Color fundus image: 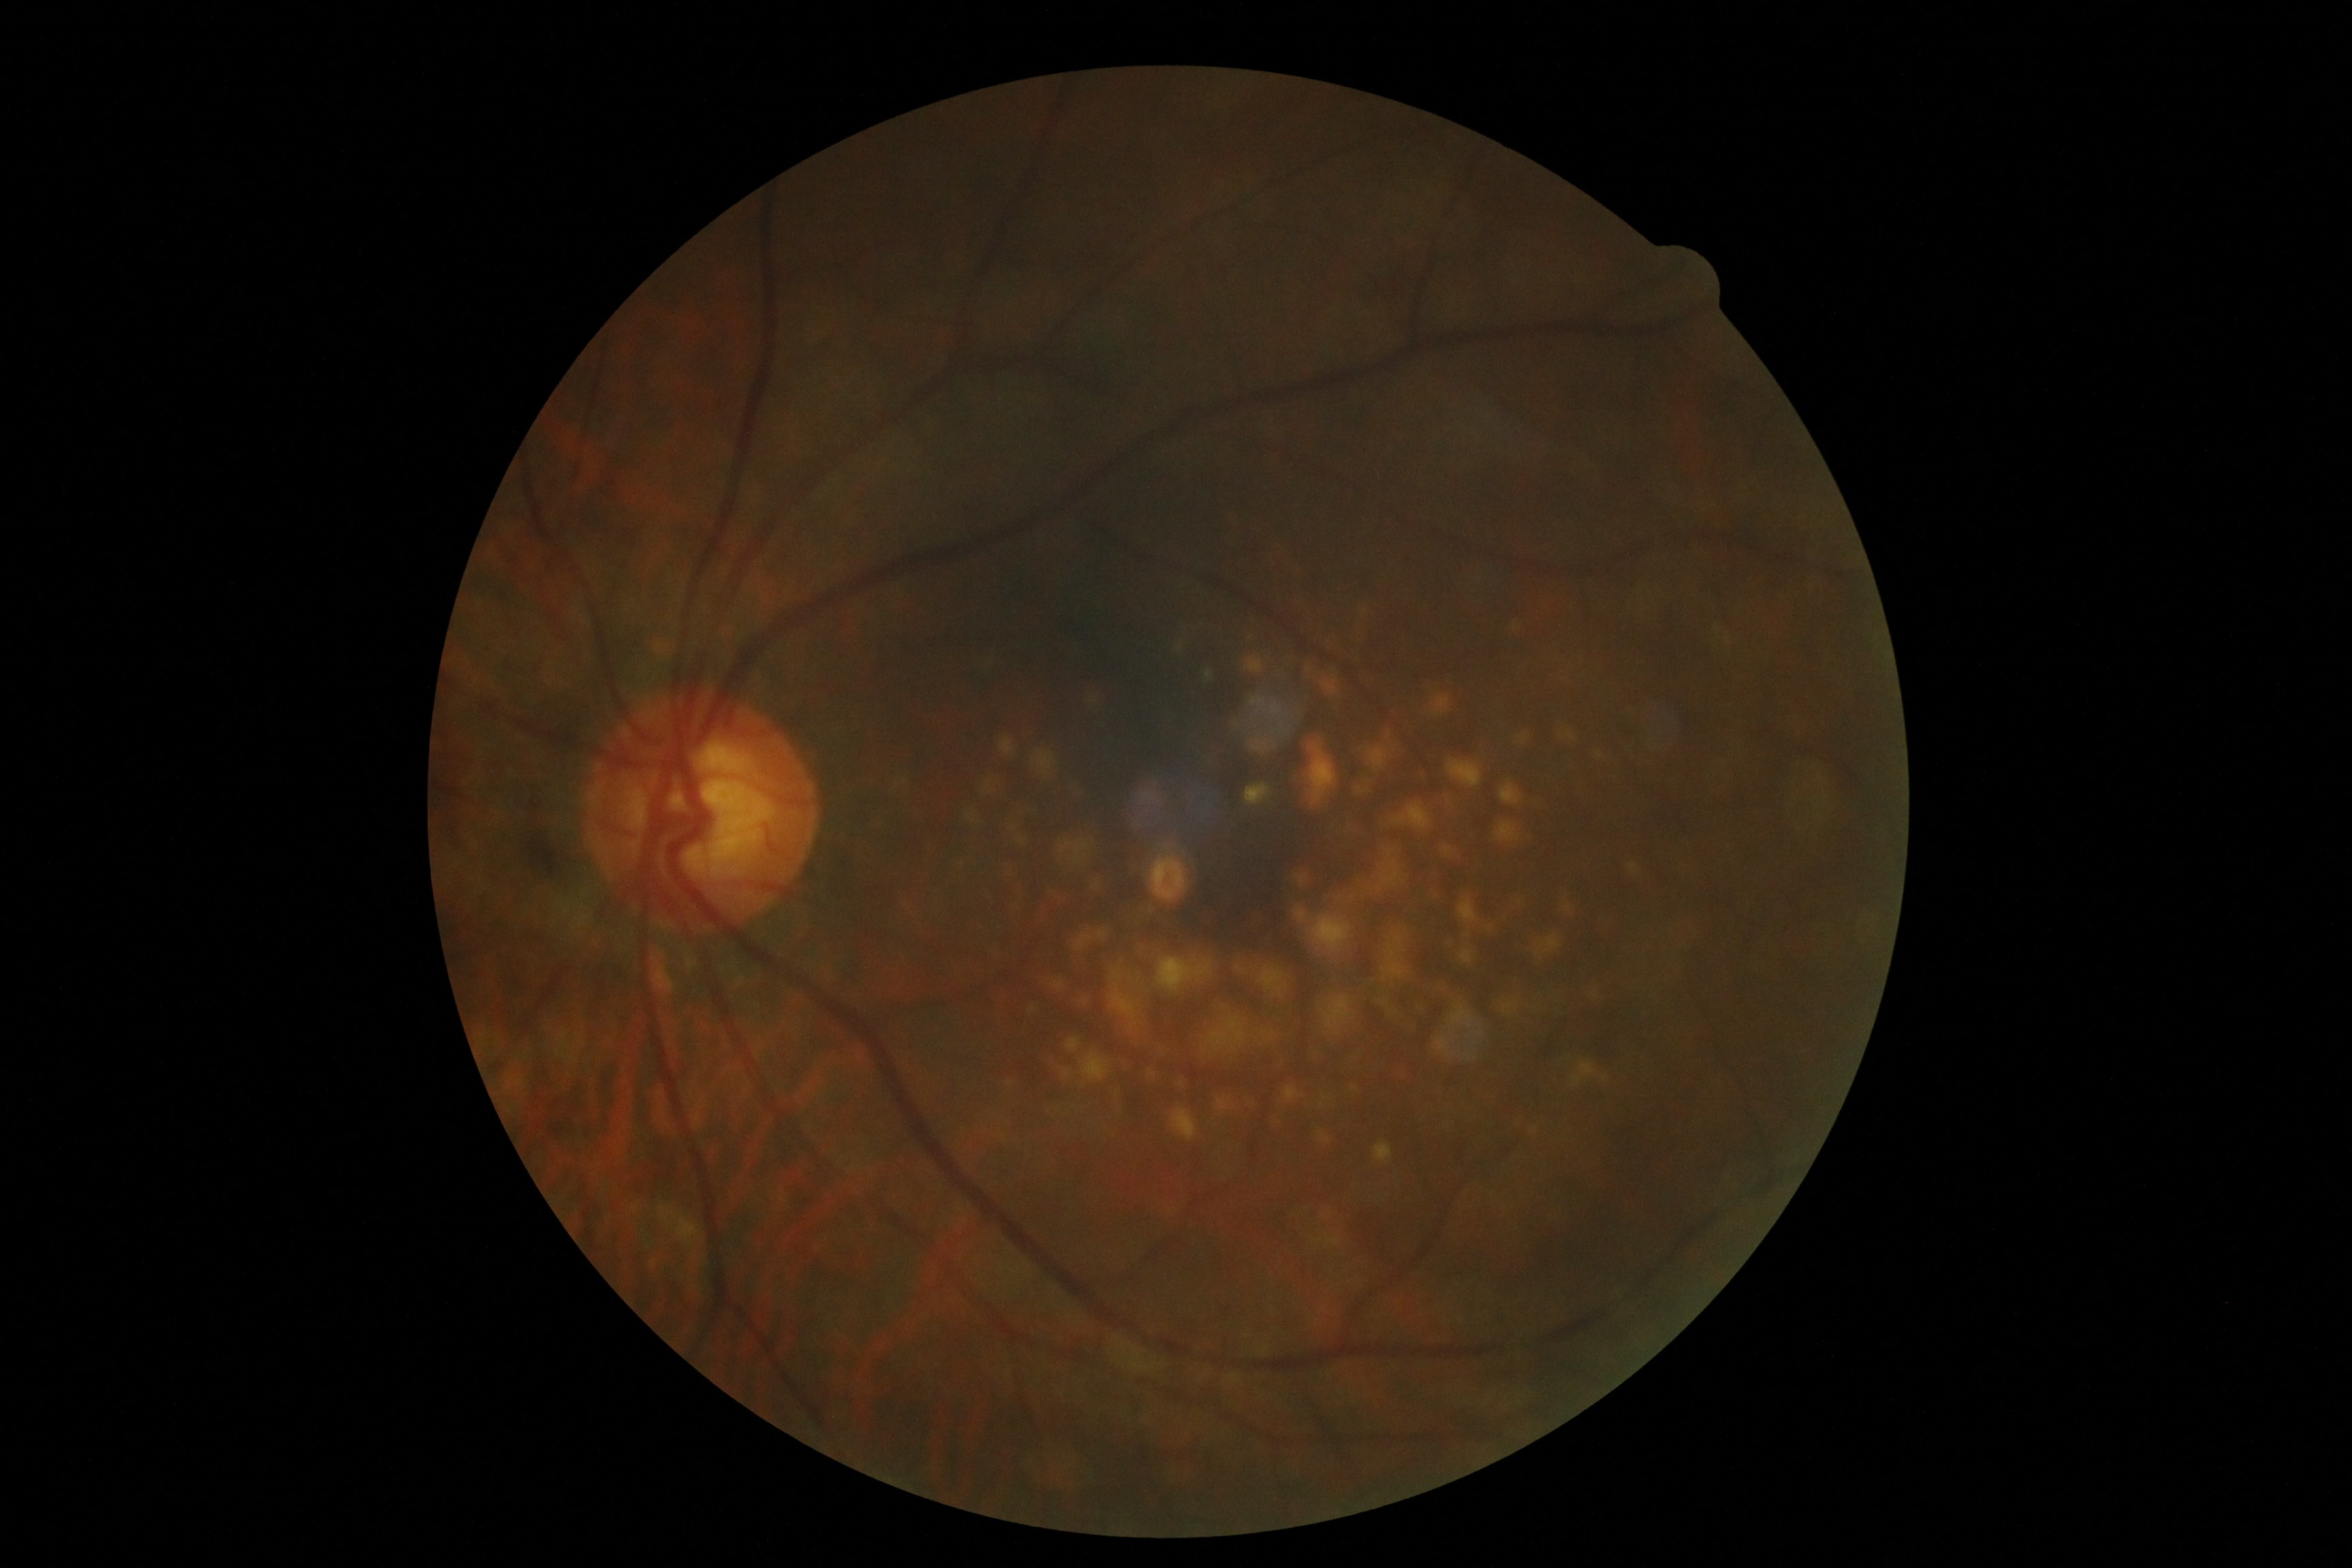 DR stage is 2/4. DR class: non-proliferative diabetic retinopathy.